CFP
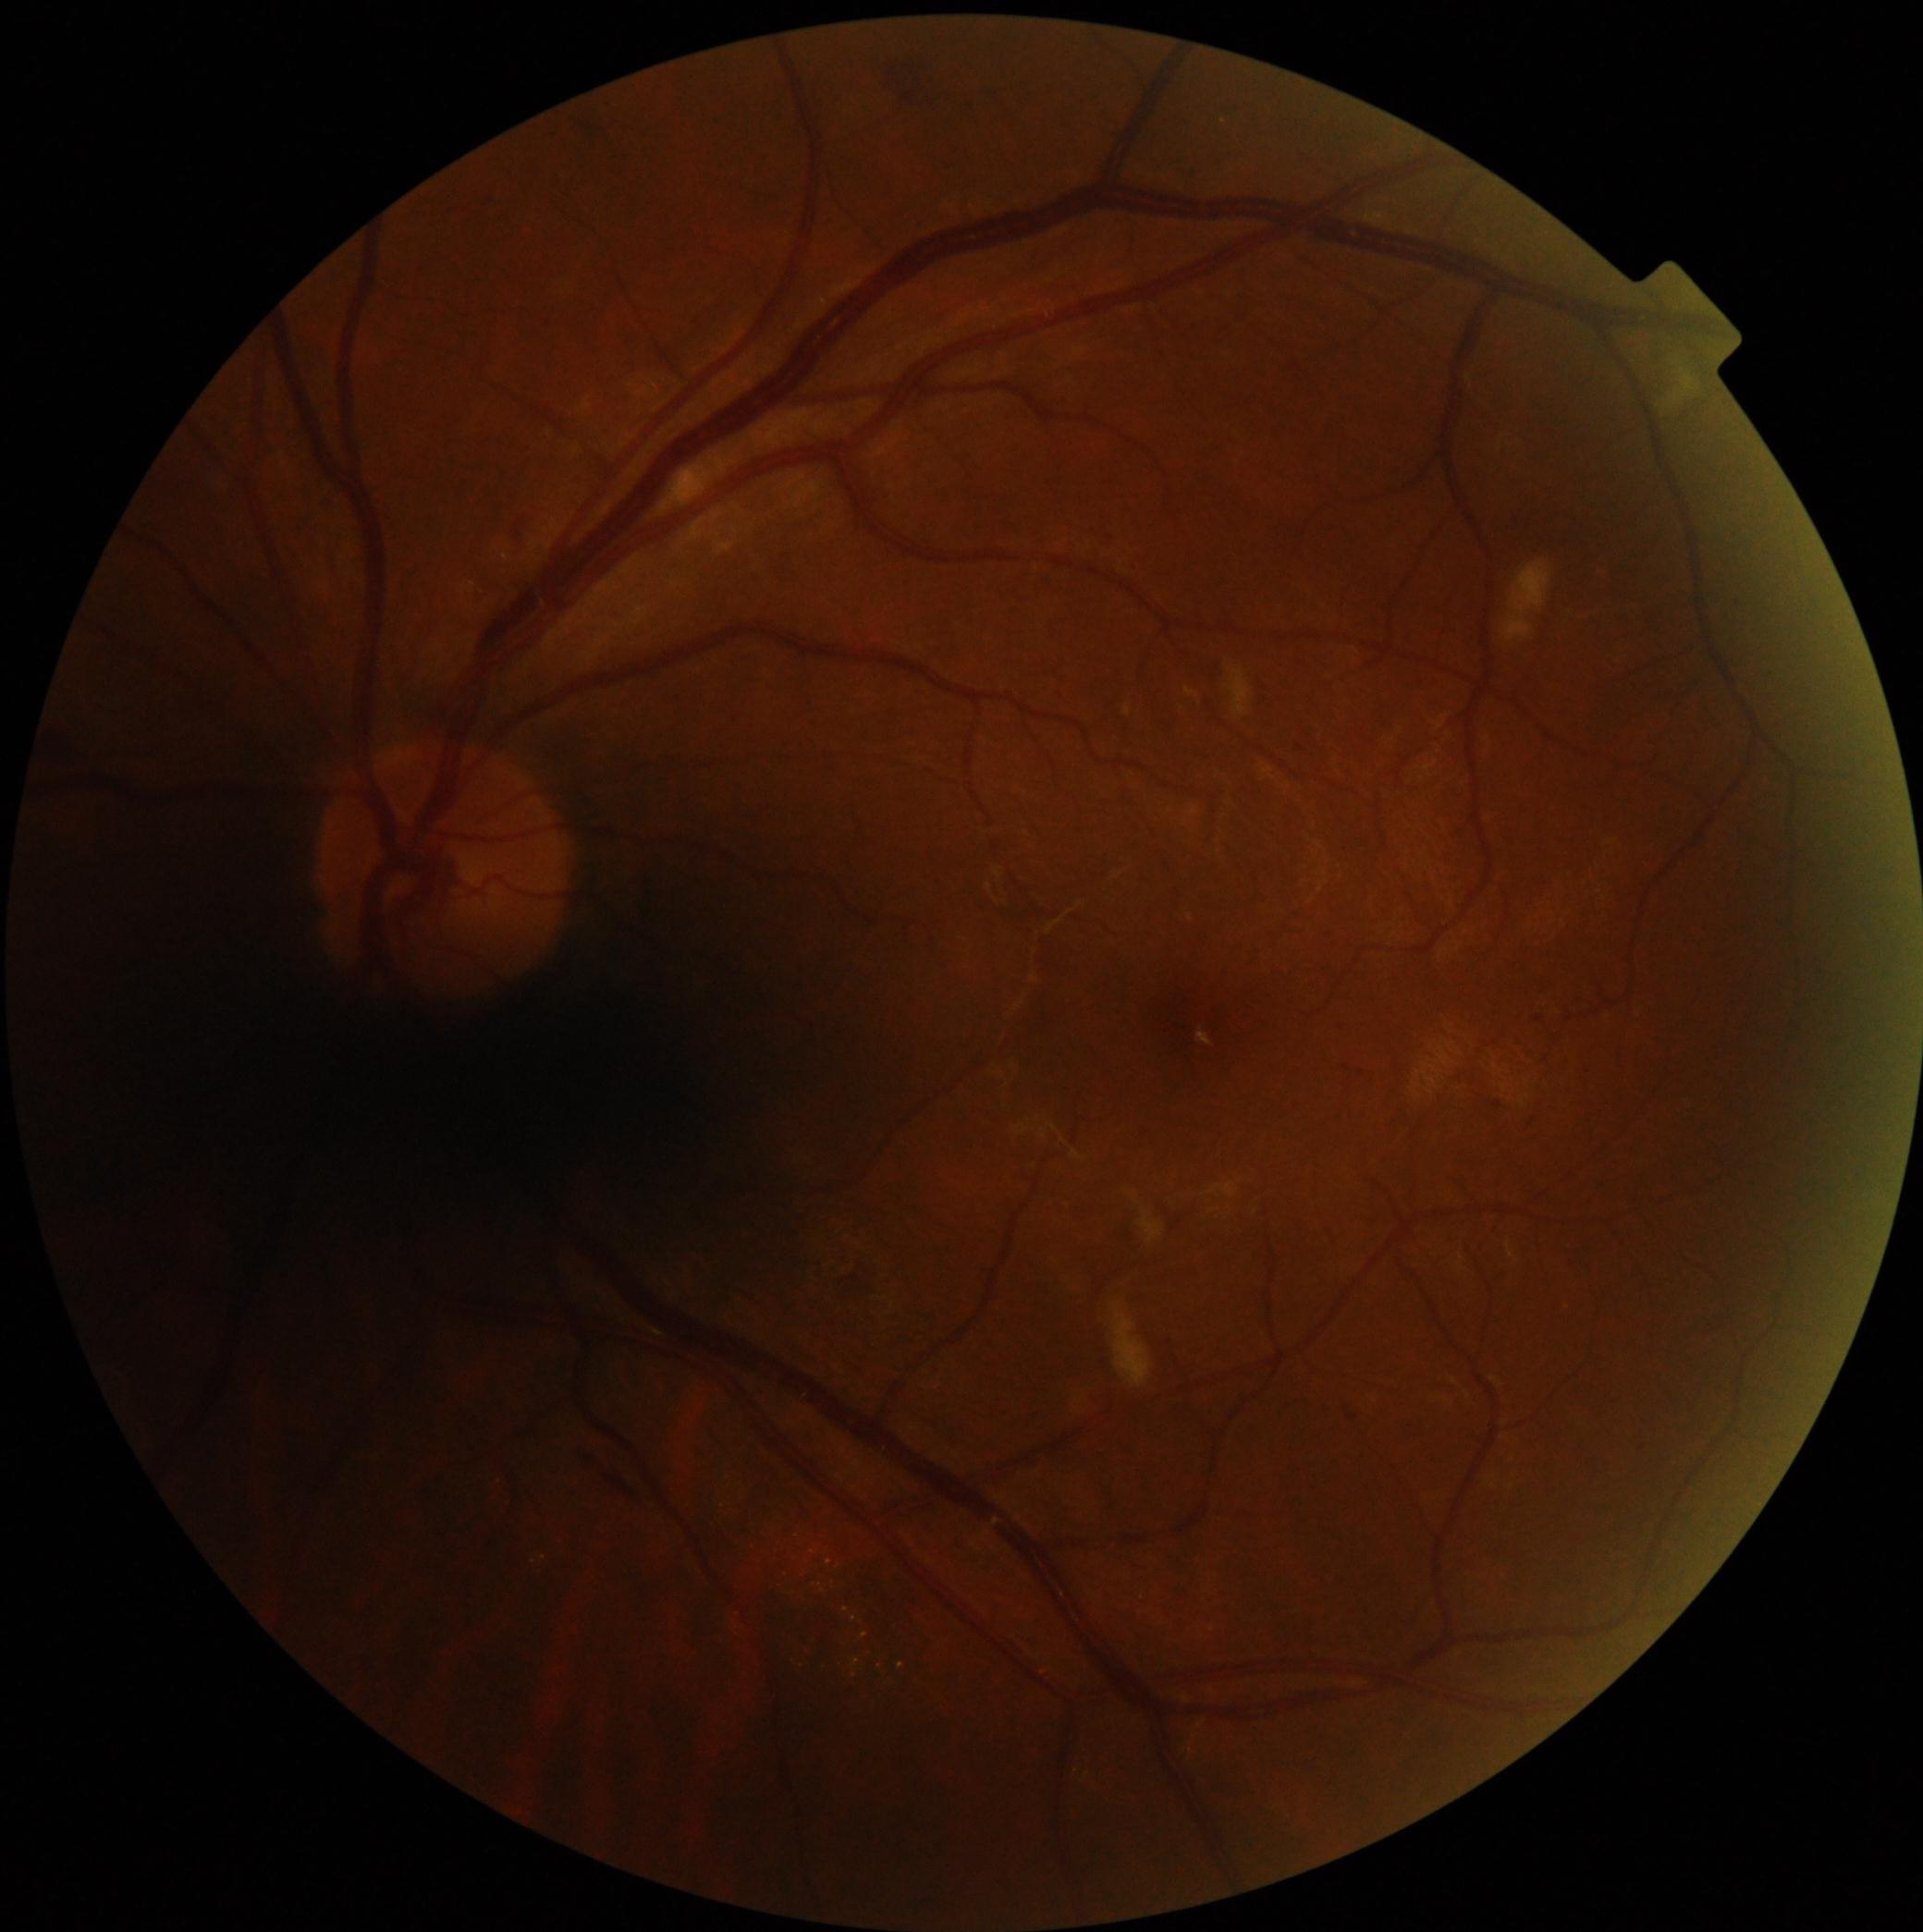 Annotations:
• DR class — non-proliferative diabetic retinopathy
• DR — grade 2 (moderate NPDR)